Optic disc-centered crop:
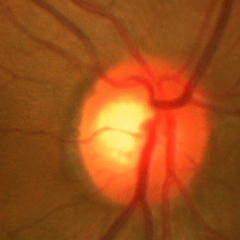

Findings consistent with glaucoma. Fundus appearance consistent with early glaucomatous optic neuropathy.